Diabetic retinopathy graded by the modified Davis classification · nonmydriatic · 848 x 848 pixels
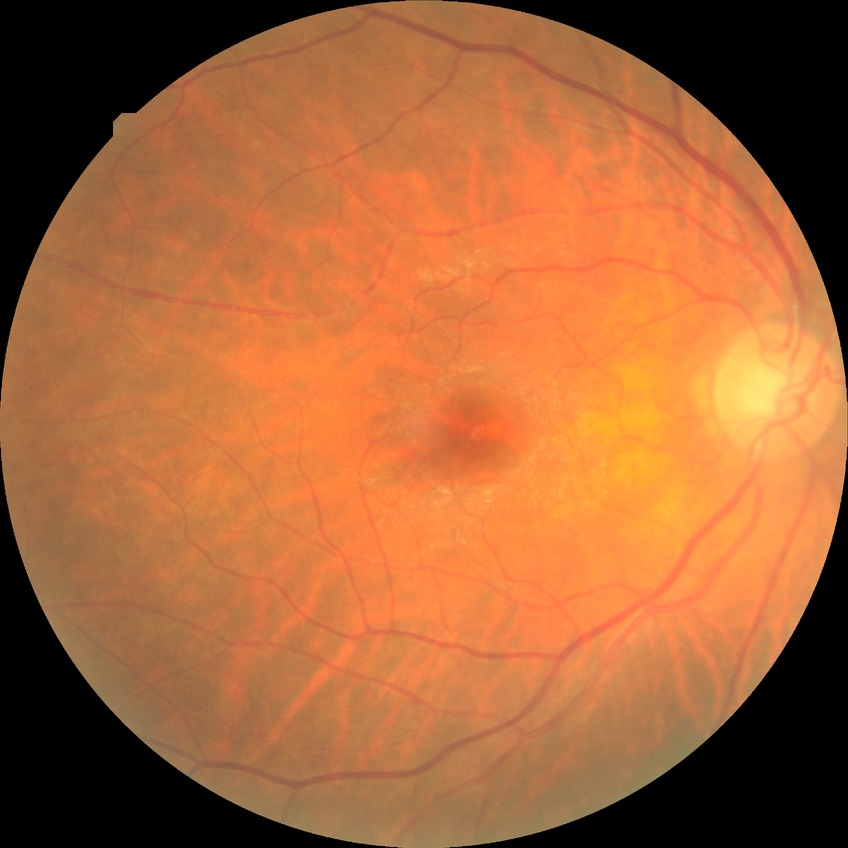

- diabetic retinopathy (DR): NDR (no diabetic retinopathy)